Undilated pupil. Intraocular pressure (IOP) by non-contact tonometry: 13 mmHg. Refractive error: +3 -0.25 × 90°: 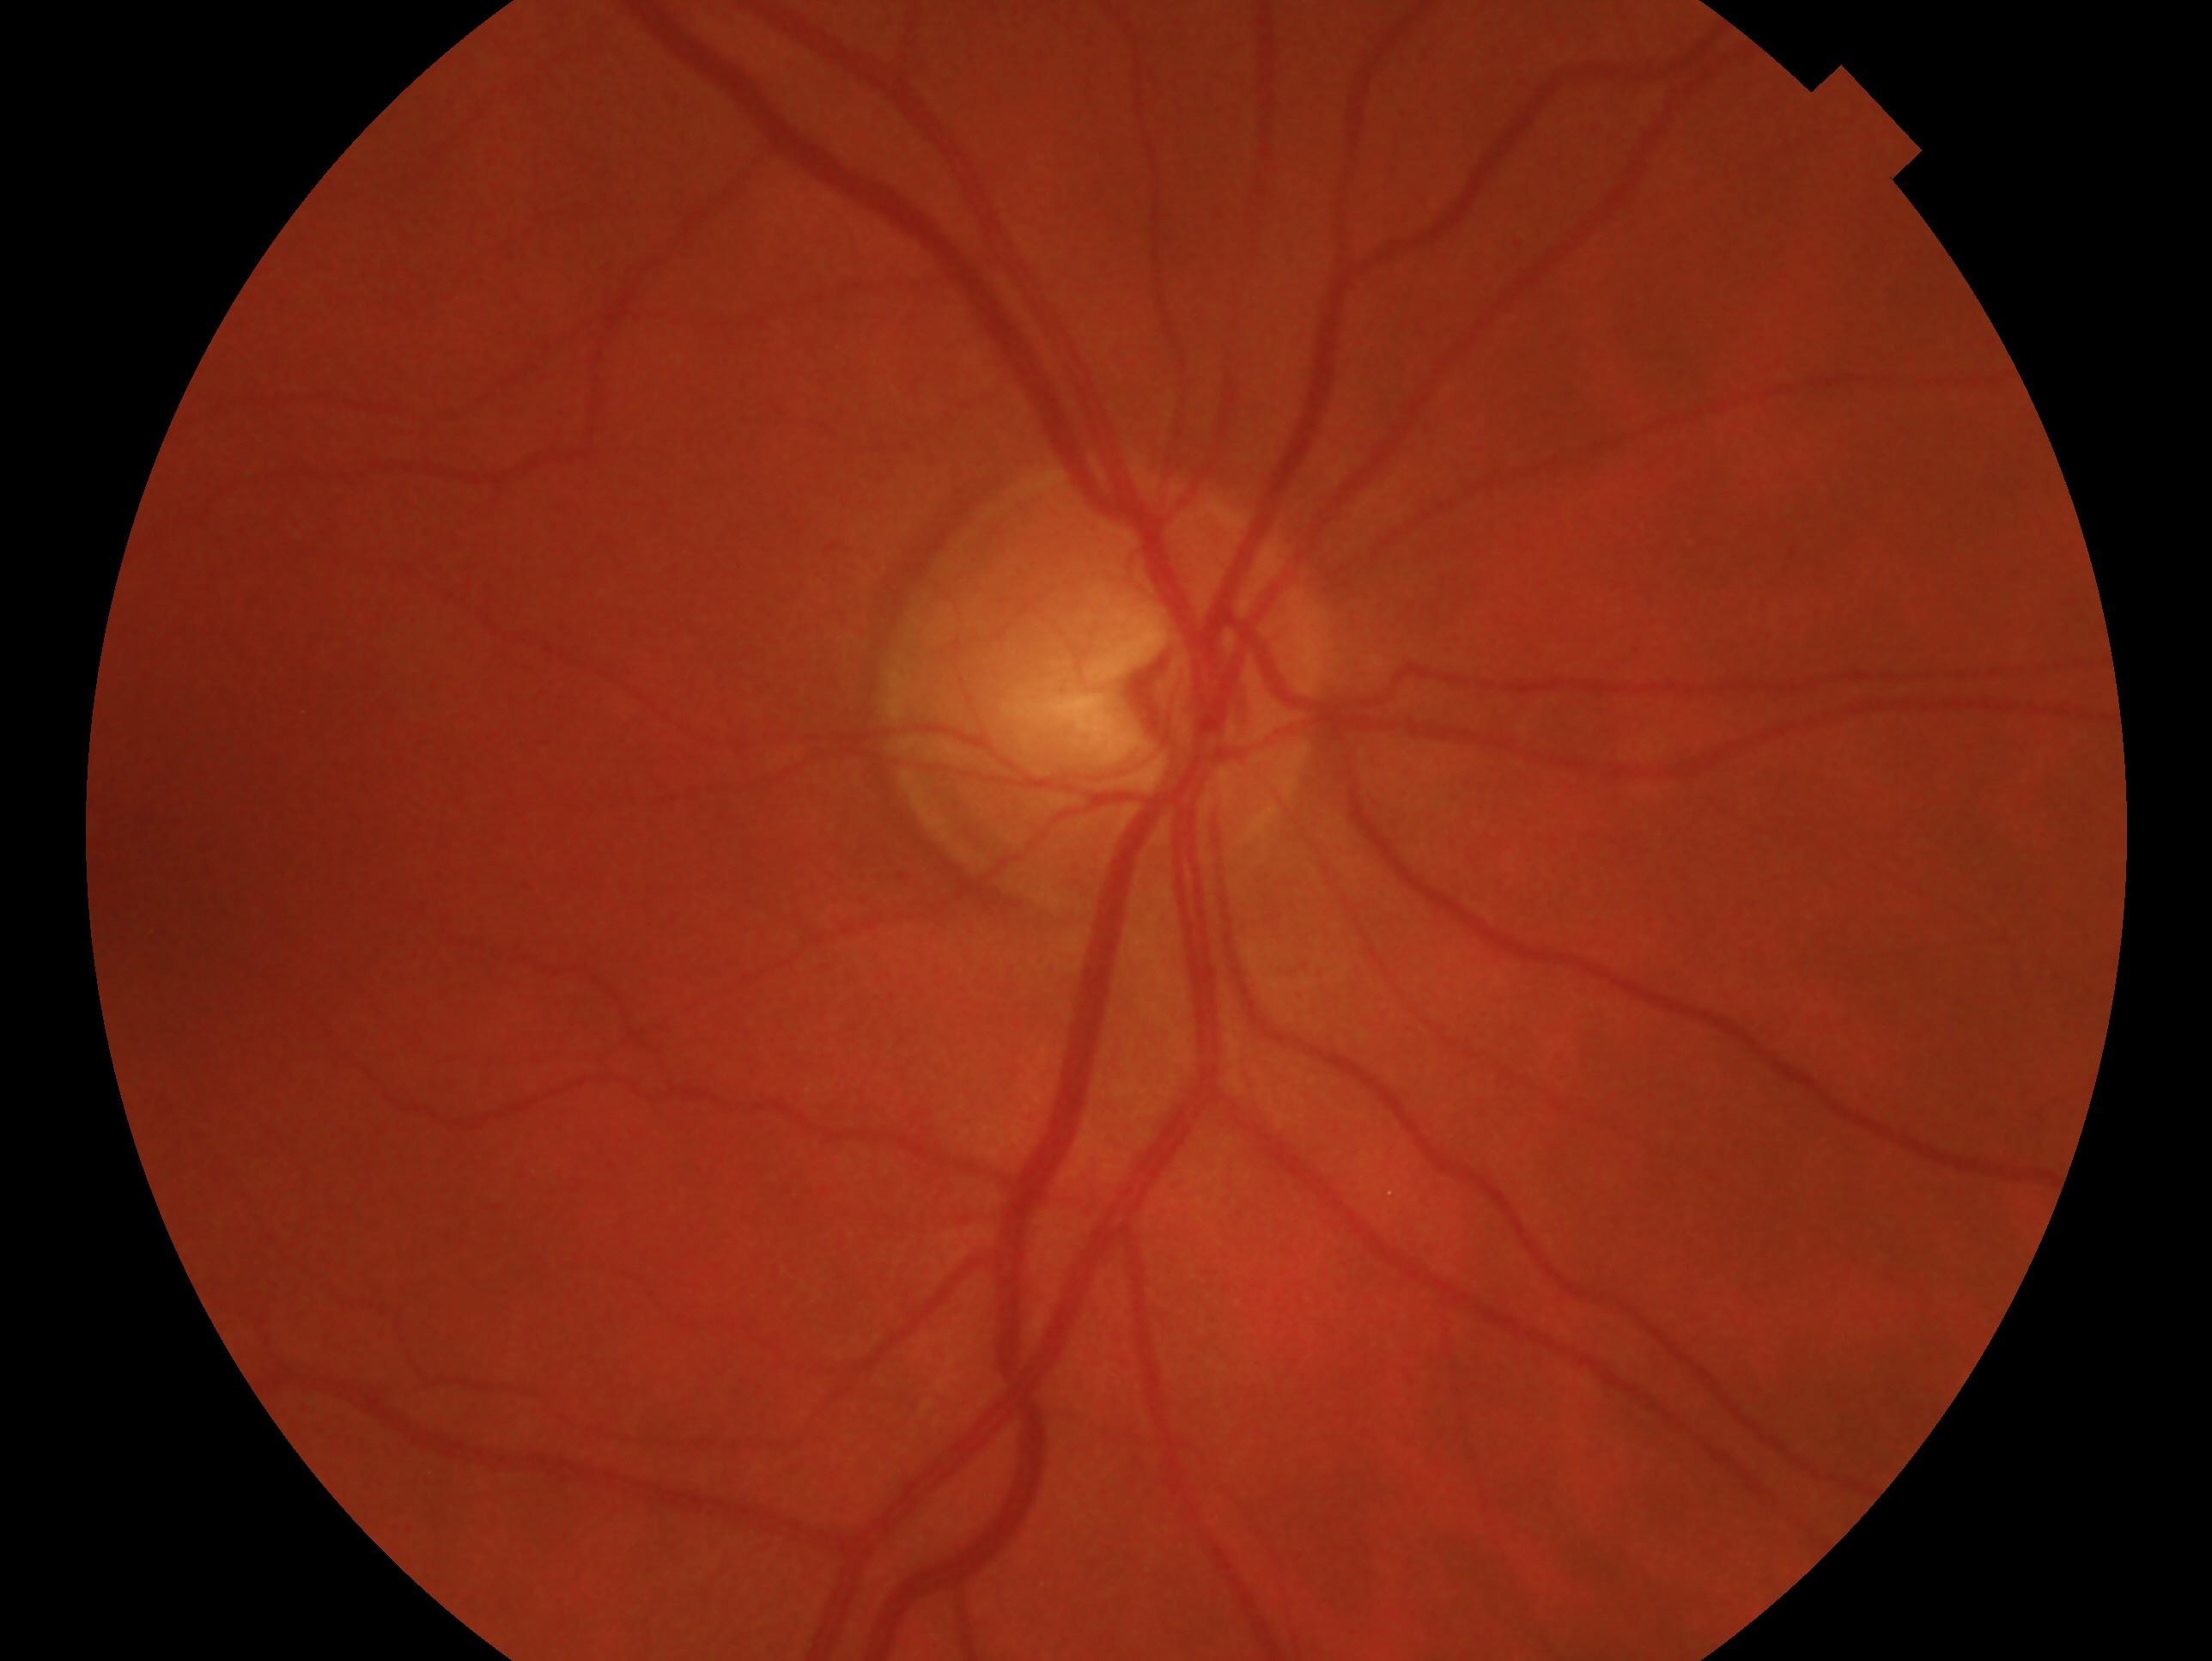

Impression: no signs of glaucoma.
Imaged eye: oculus dexter.